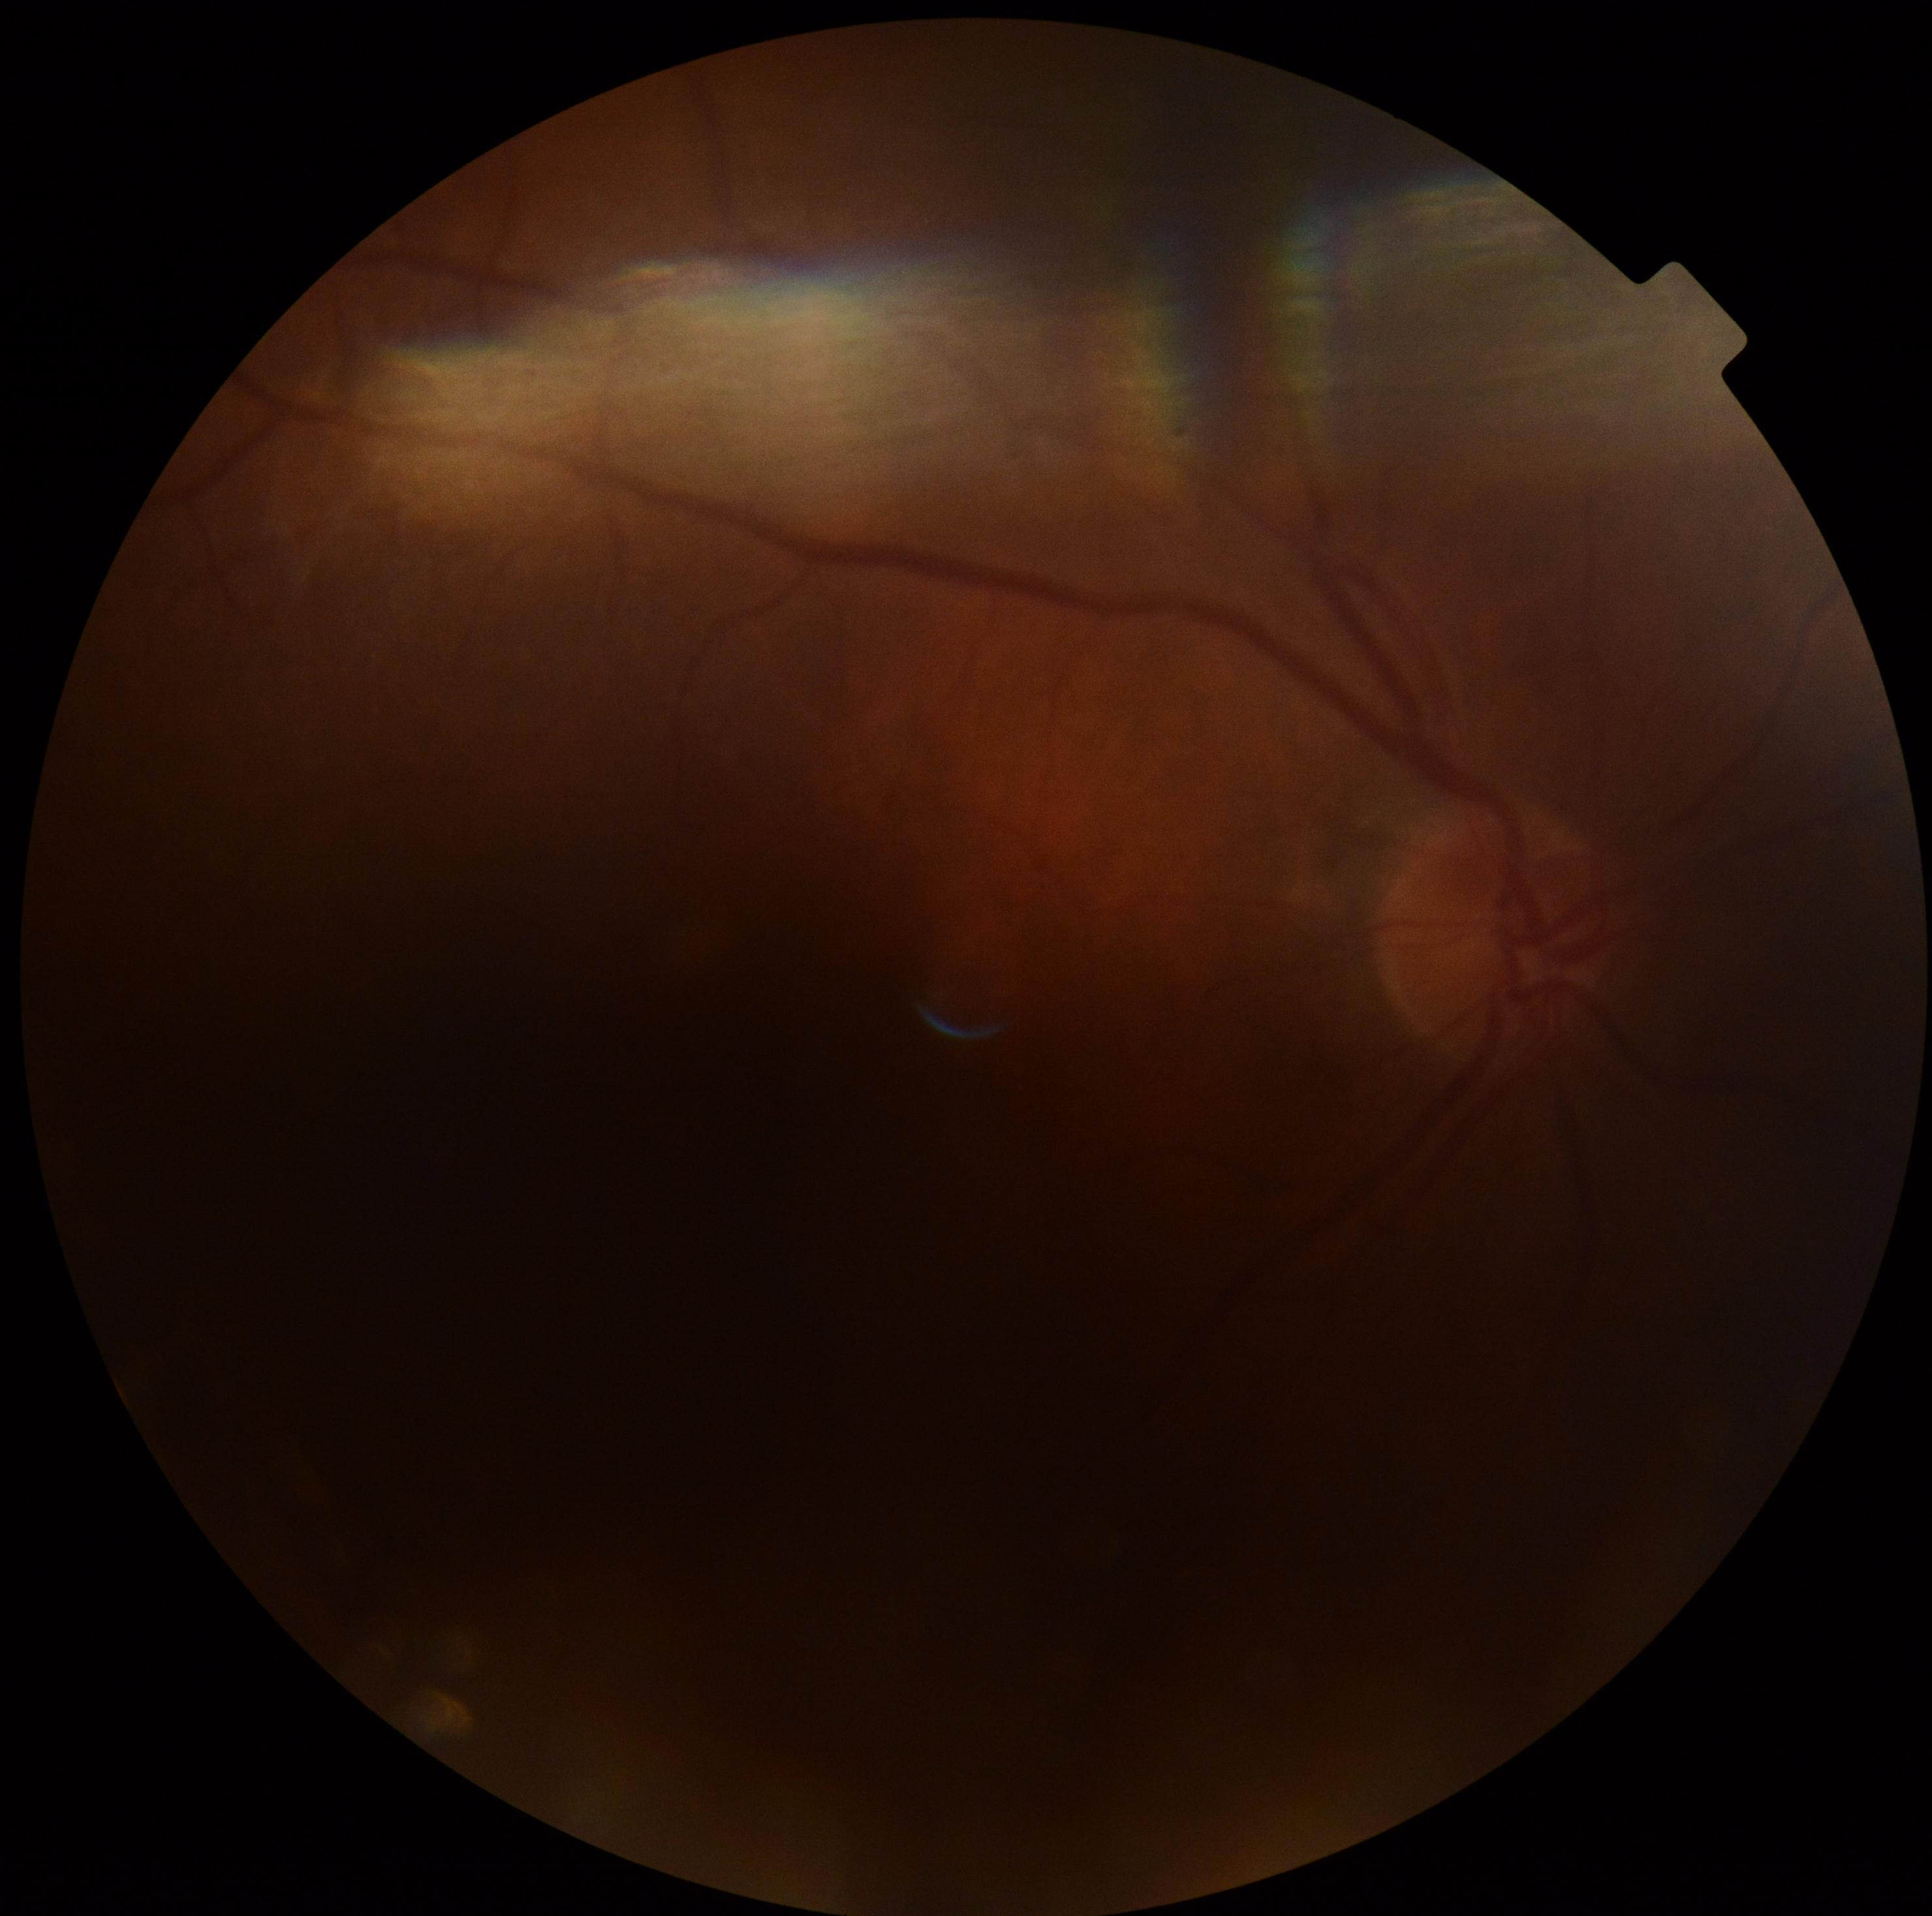 image quality = insufficient
diabetic retinopathy severity = ungradable due to poor image quality